Infant wide-field retinal image · captured with the Clarity RetCam 3 (130° field of view):
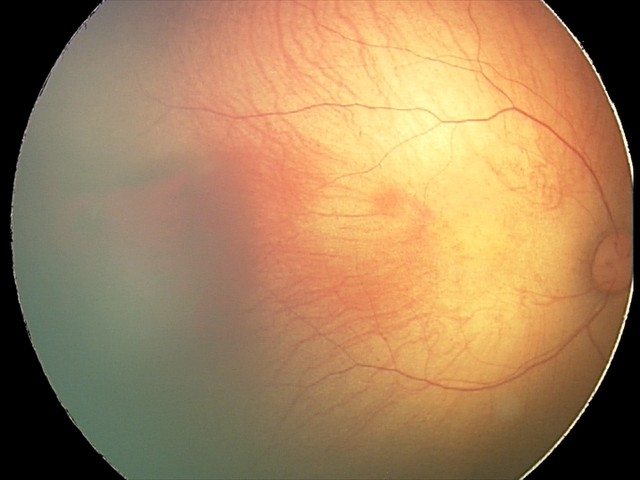

Screening series with retinal hemorrhages.